Camera: NIDEK AFC-230; nonmydriatic; CFP; 848 by 848 pixels; graded on the modified Davis scale
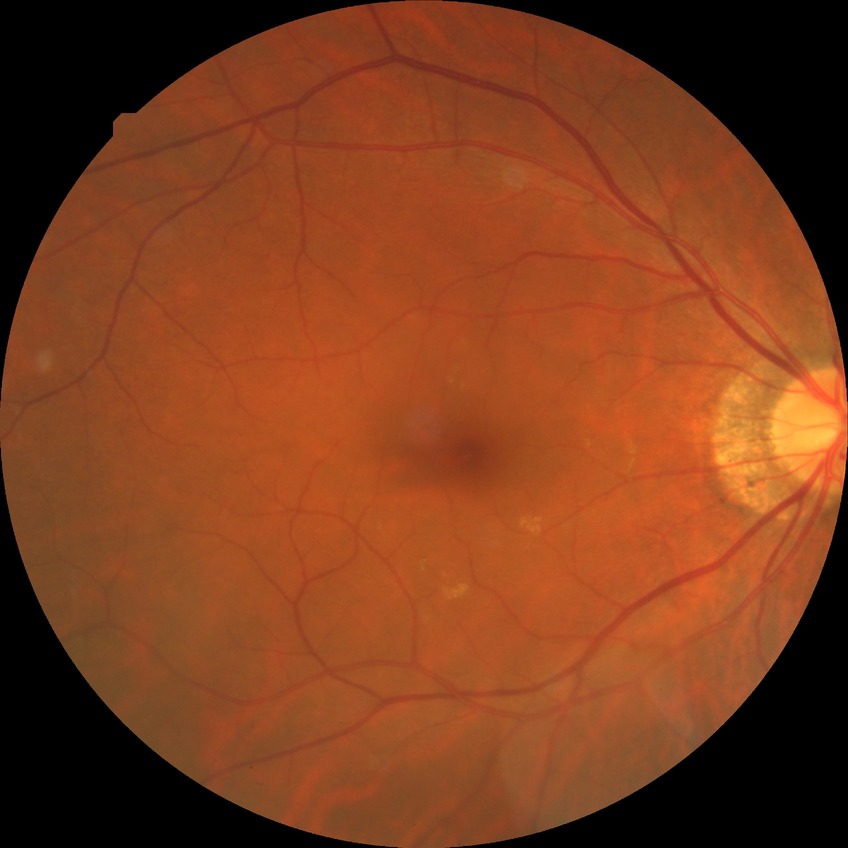

Diabetic retinopathy grade: no diabetic retinopathy.